50° FOV:
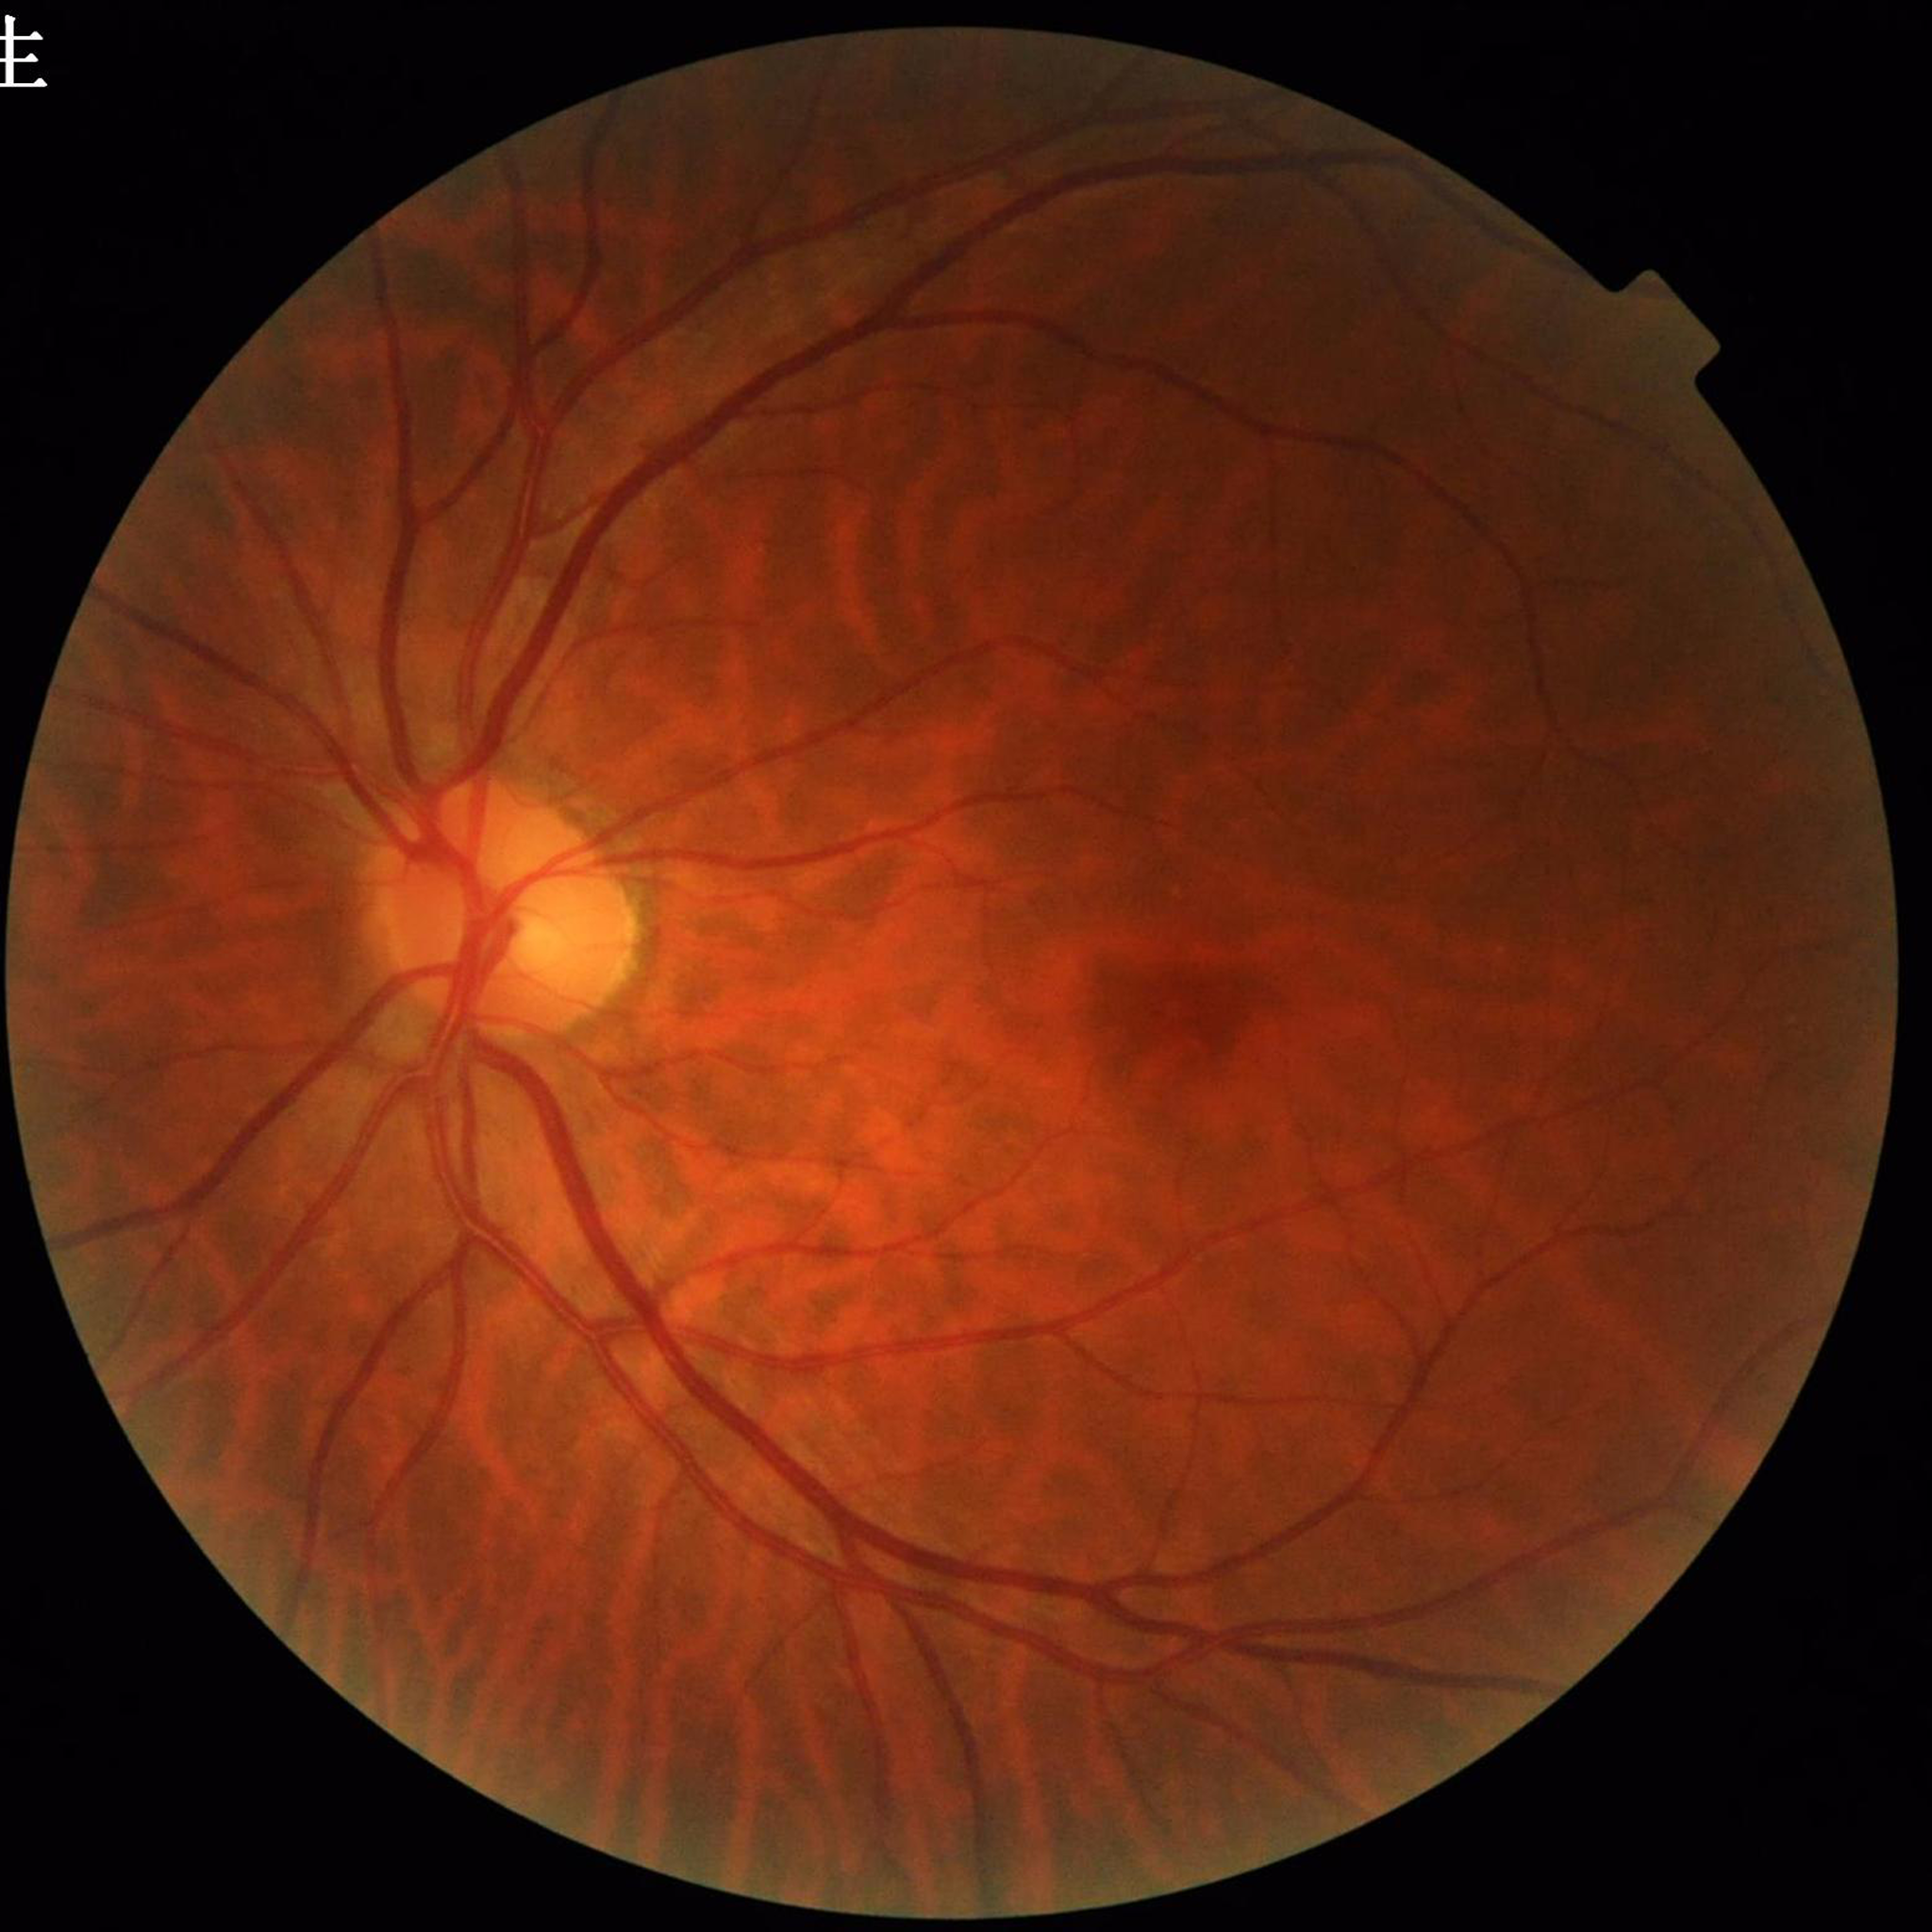
Diagnosed with glaucoma.